Wide-field fundus photograph from neonatal ROP screening.
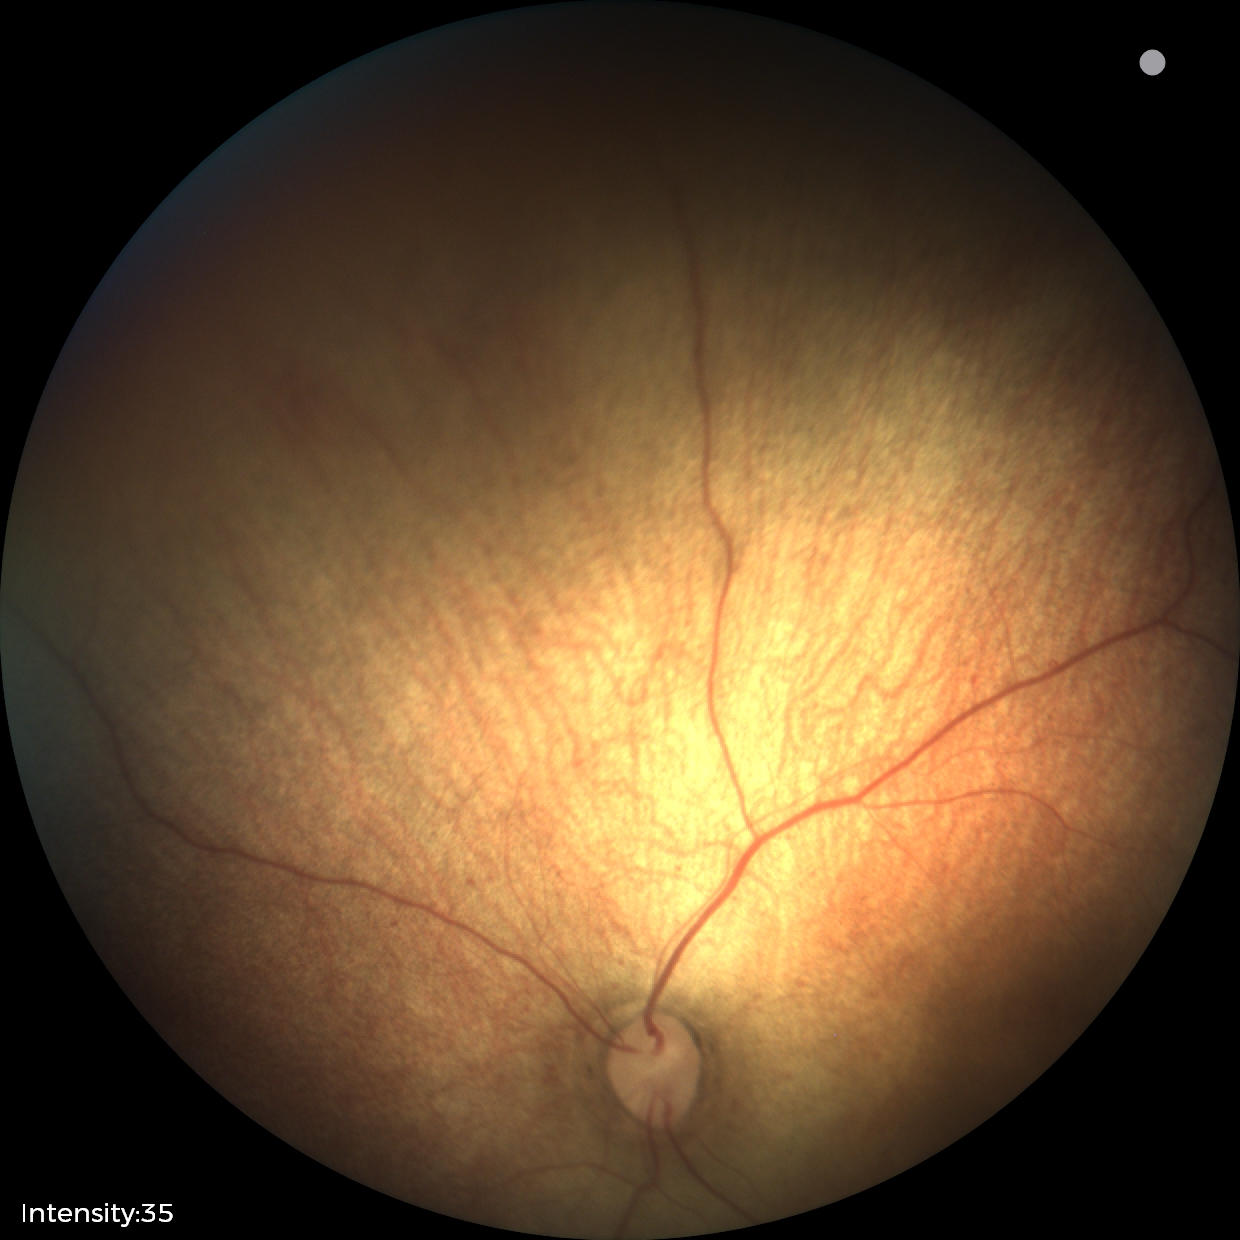 Screening diagnosis: normal.